2212 x 1659 pixels — 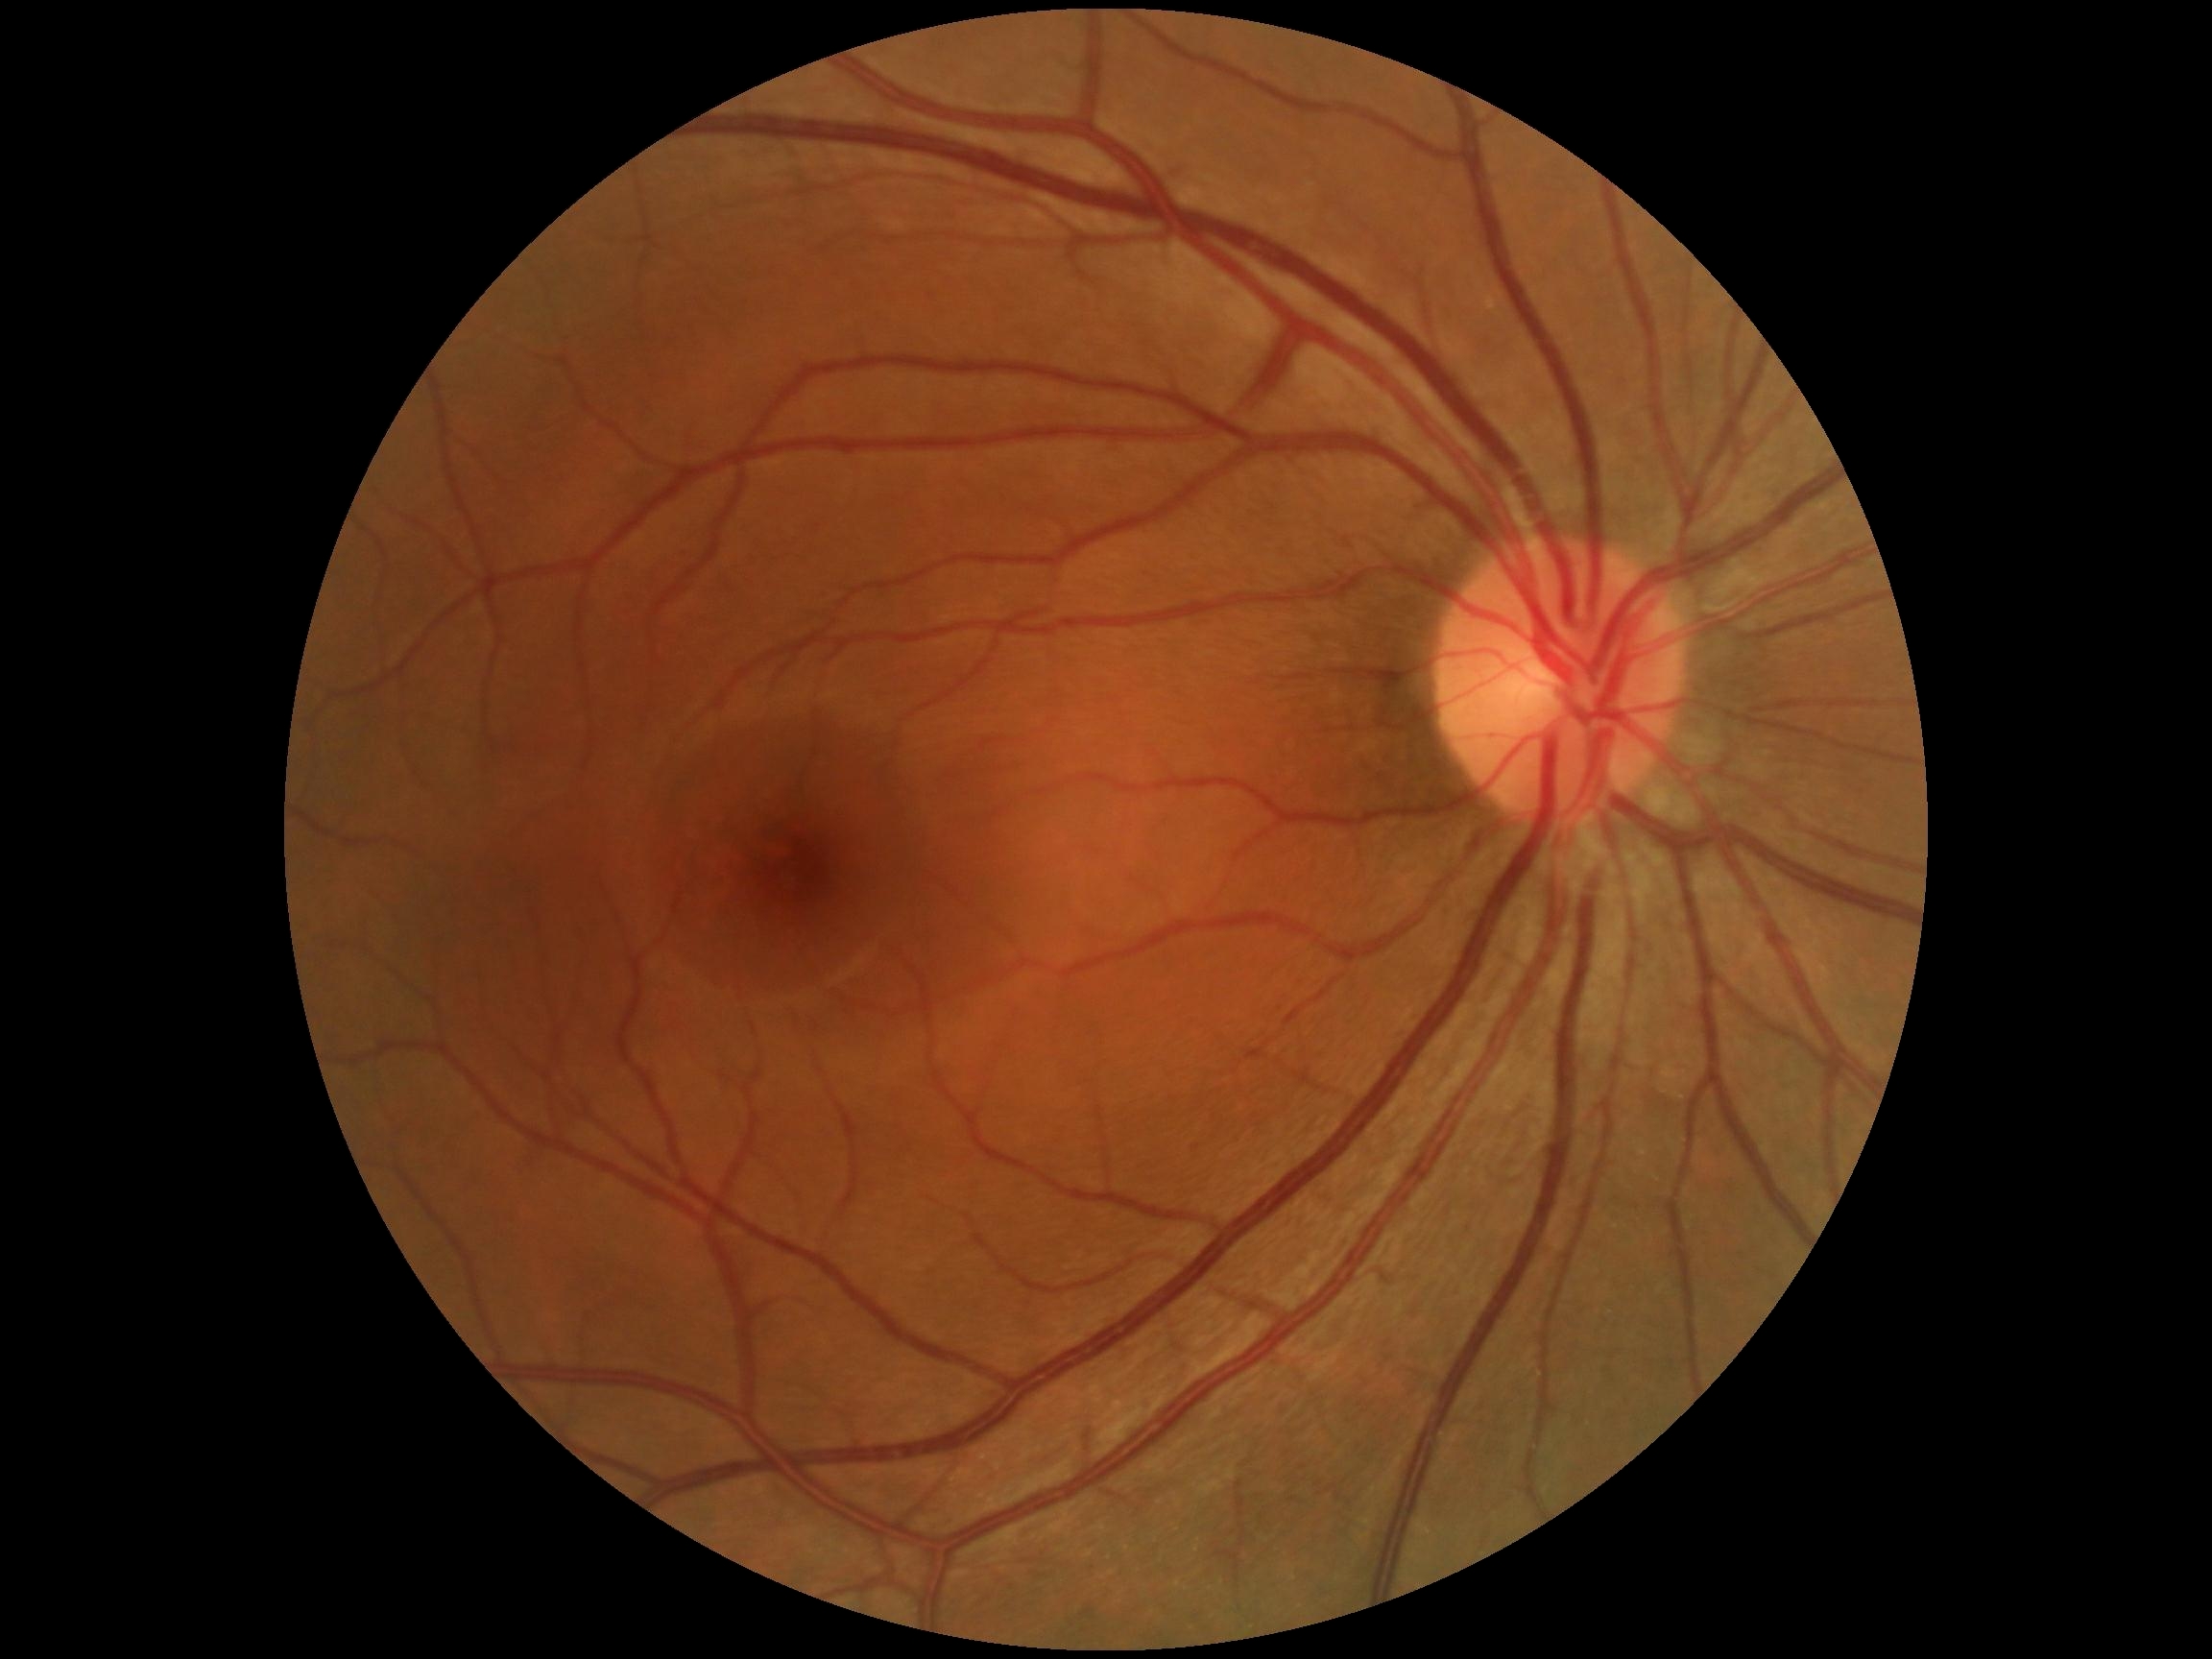 Diabetic retinopathy (DR) is grade 0. No signs of diabetic retinopathy.